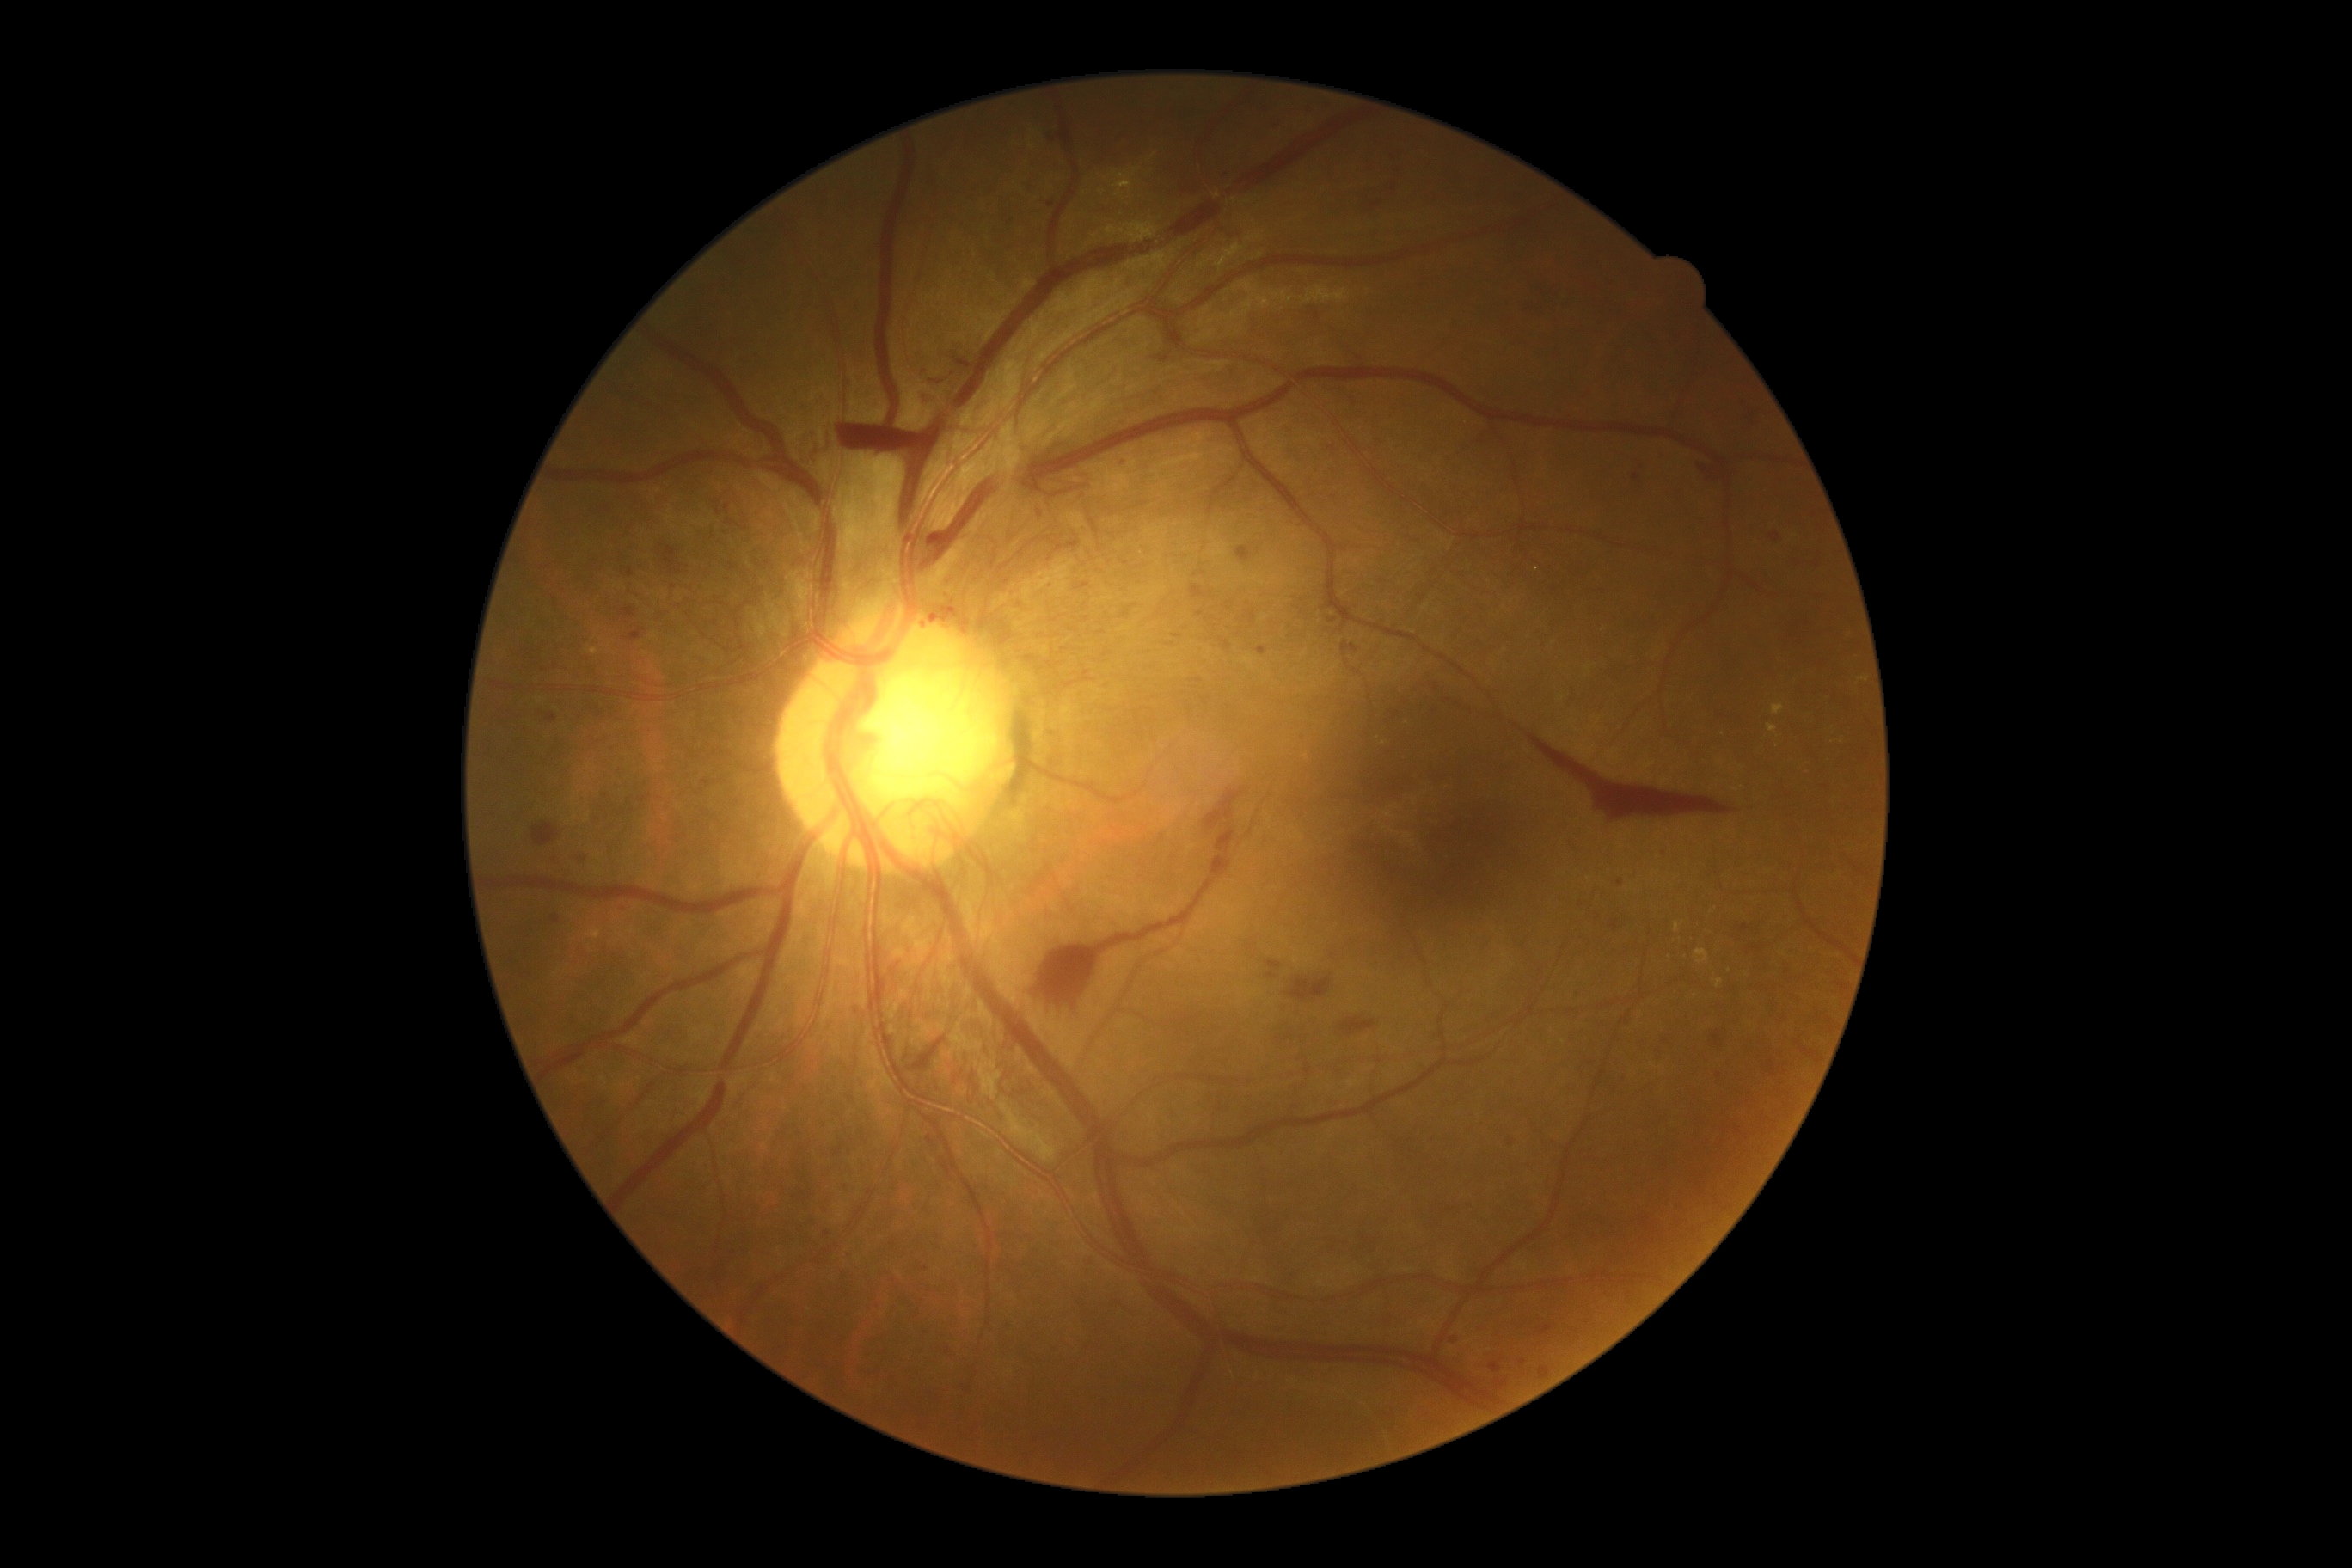

Retinopathy is proliferative diabetic retinopathy (grade 4).